512x512.
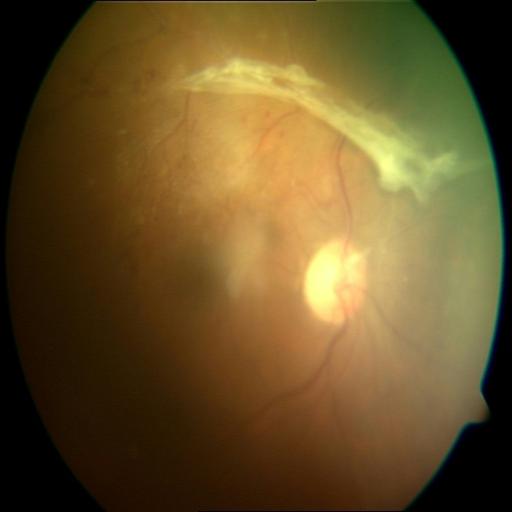

The image shows retinal traction.